Davis DR grading, without pupil dilation: 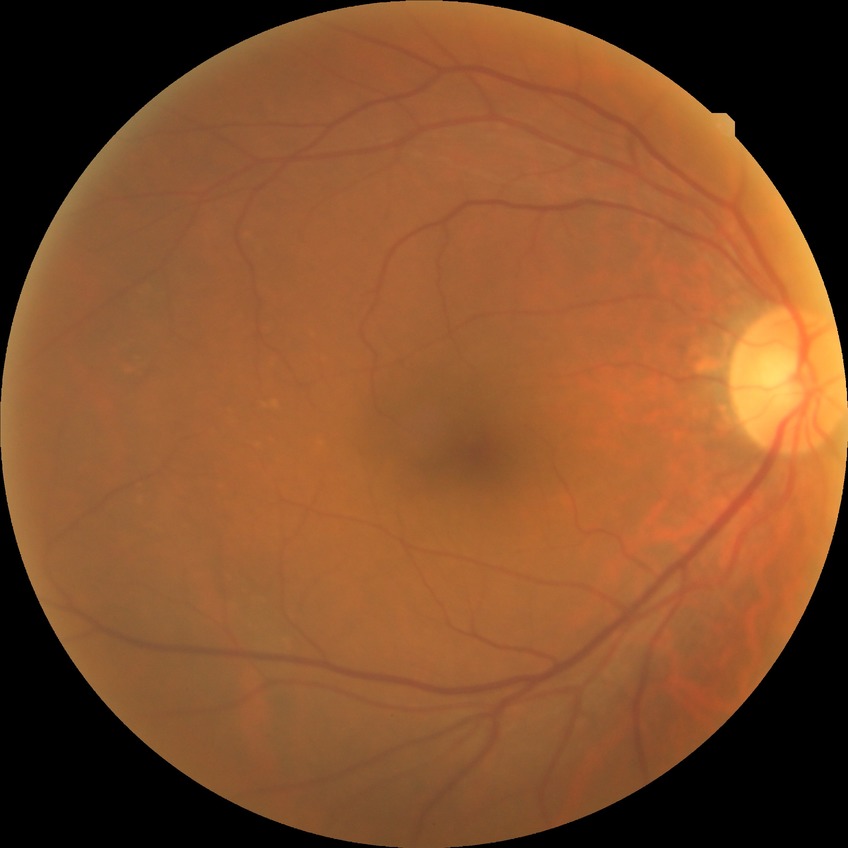

Diabetic retinopathy (DR): NDR (no diabetic retinopathy).